Posterior pole photograph, 848 x 848 pixels, 45° FOV: 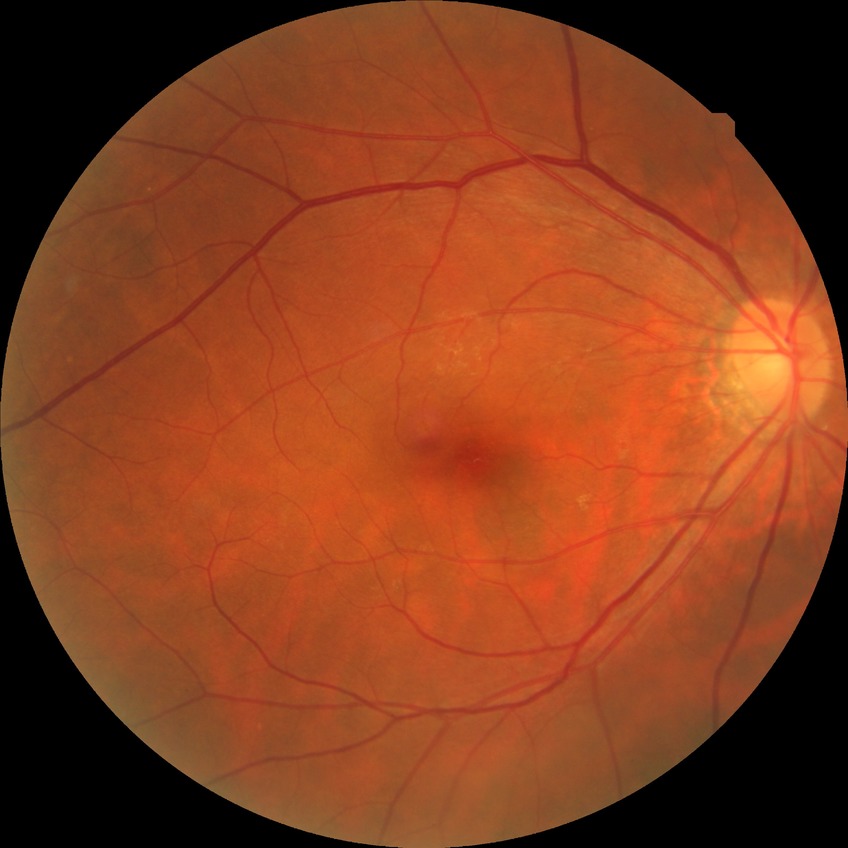
Diabetic retinopathy (DR) is no diabetic retinopathy (NDR).